Modified Davis grading — 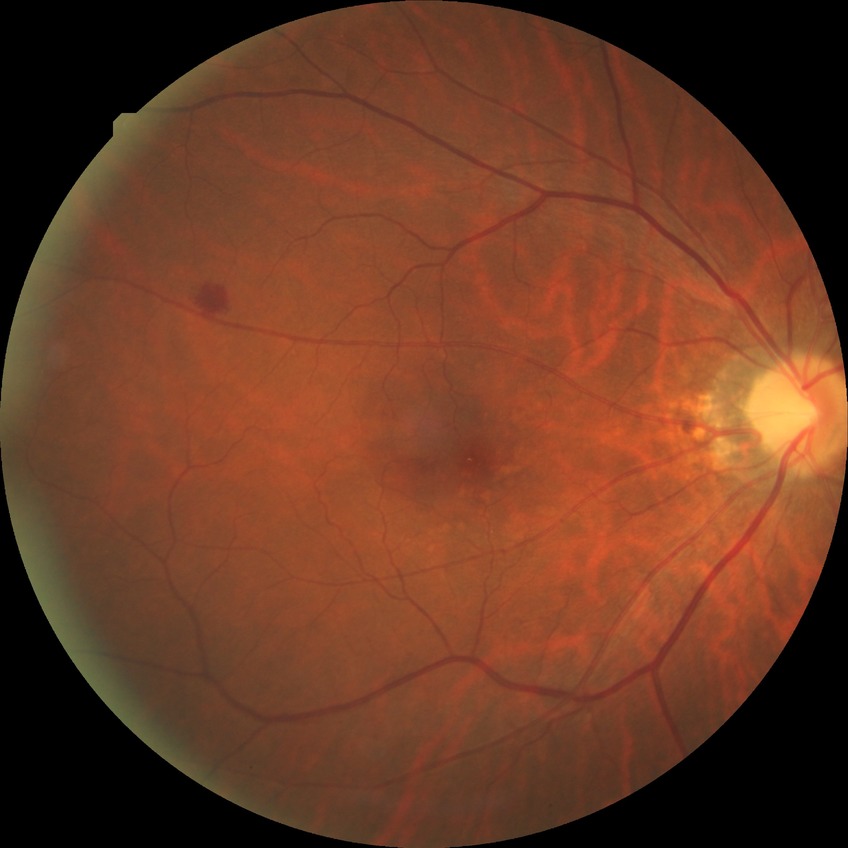
Diabetic retinopathy stage is simple diabetic retinopathy.
Disease class: non-proliferative diabetic retinopathy.